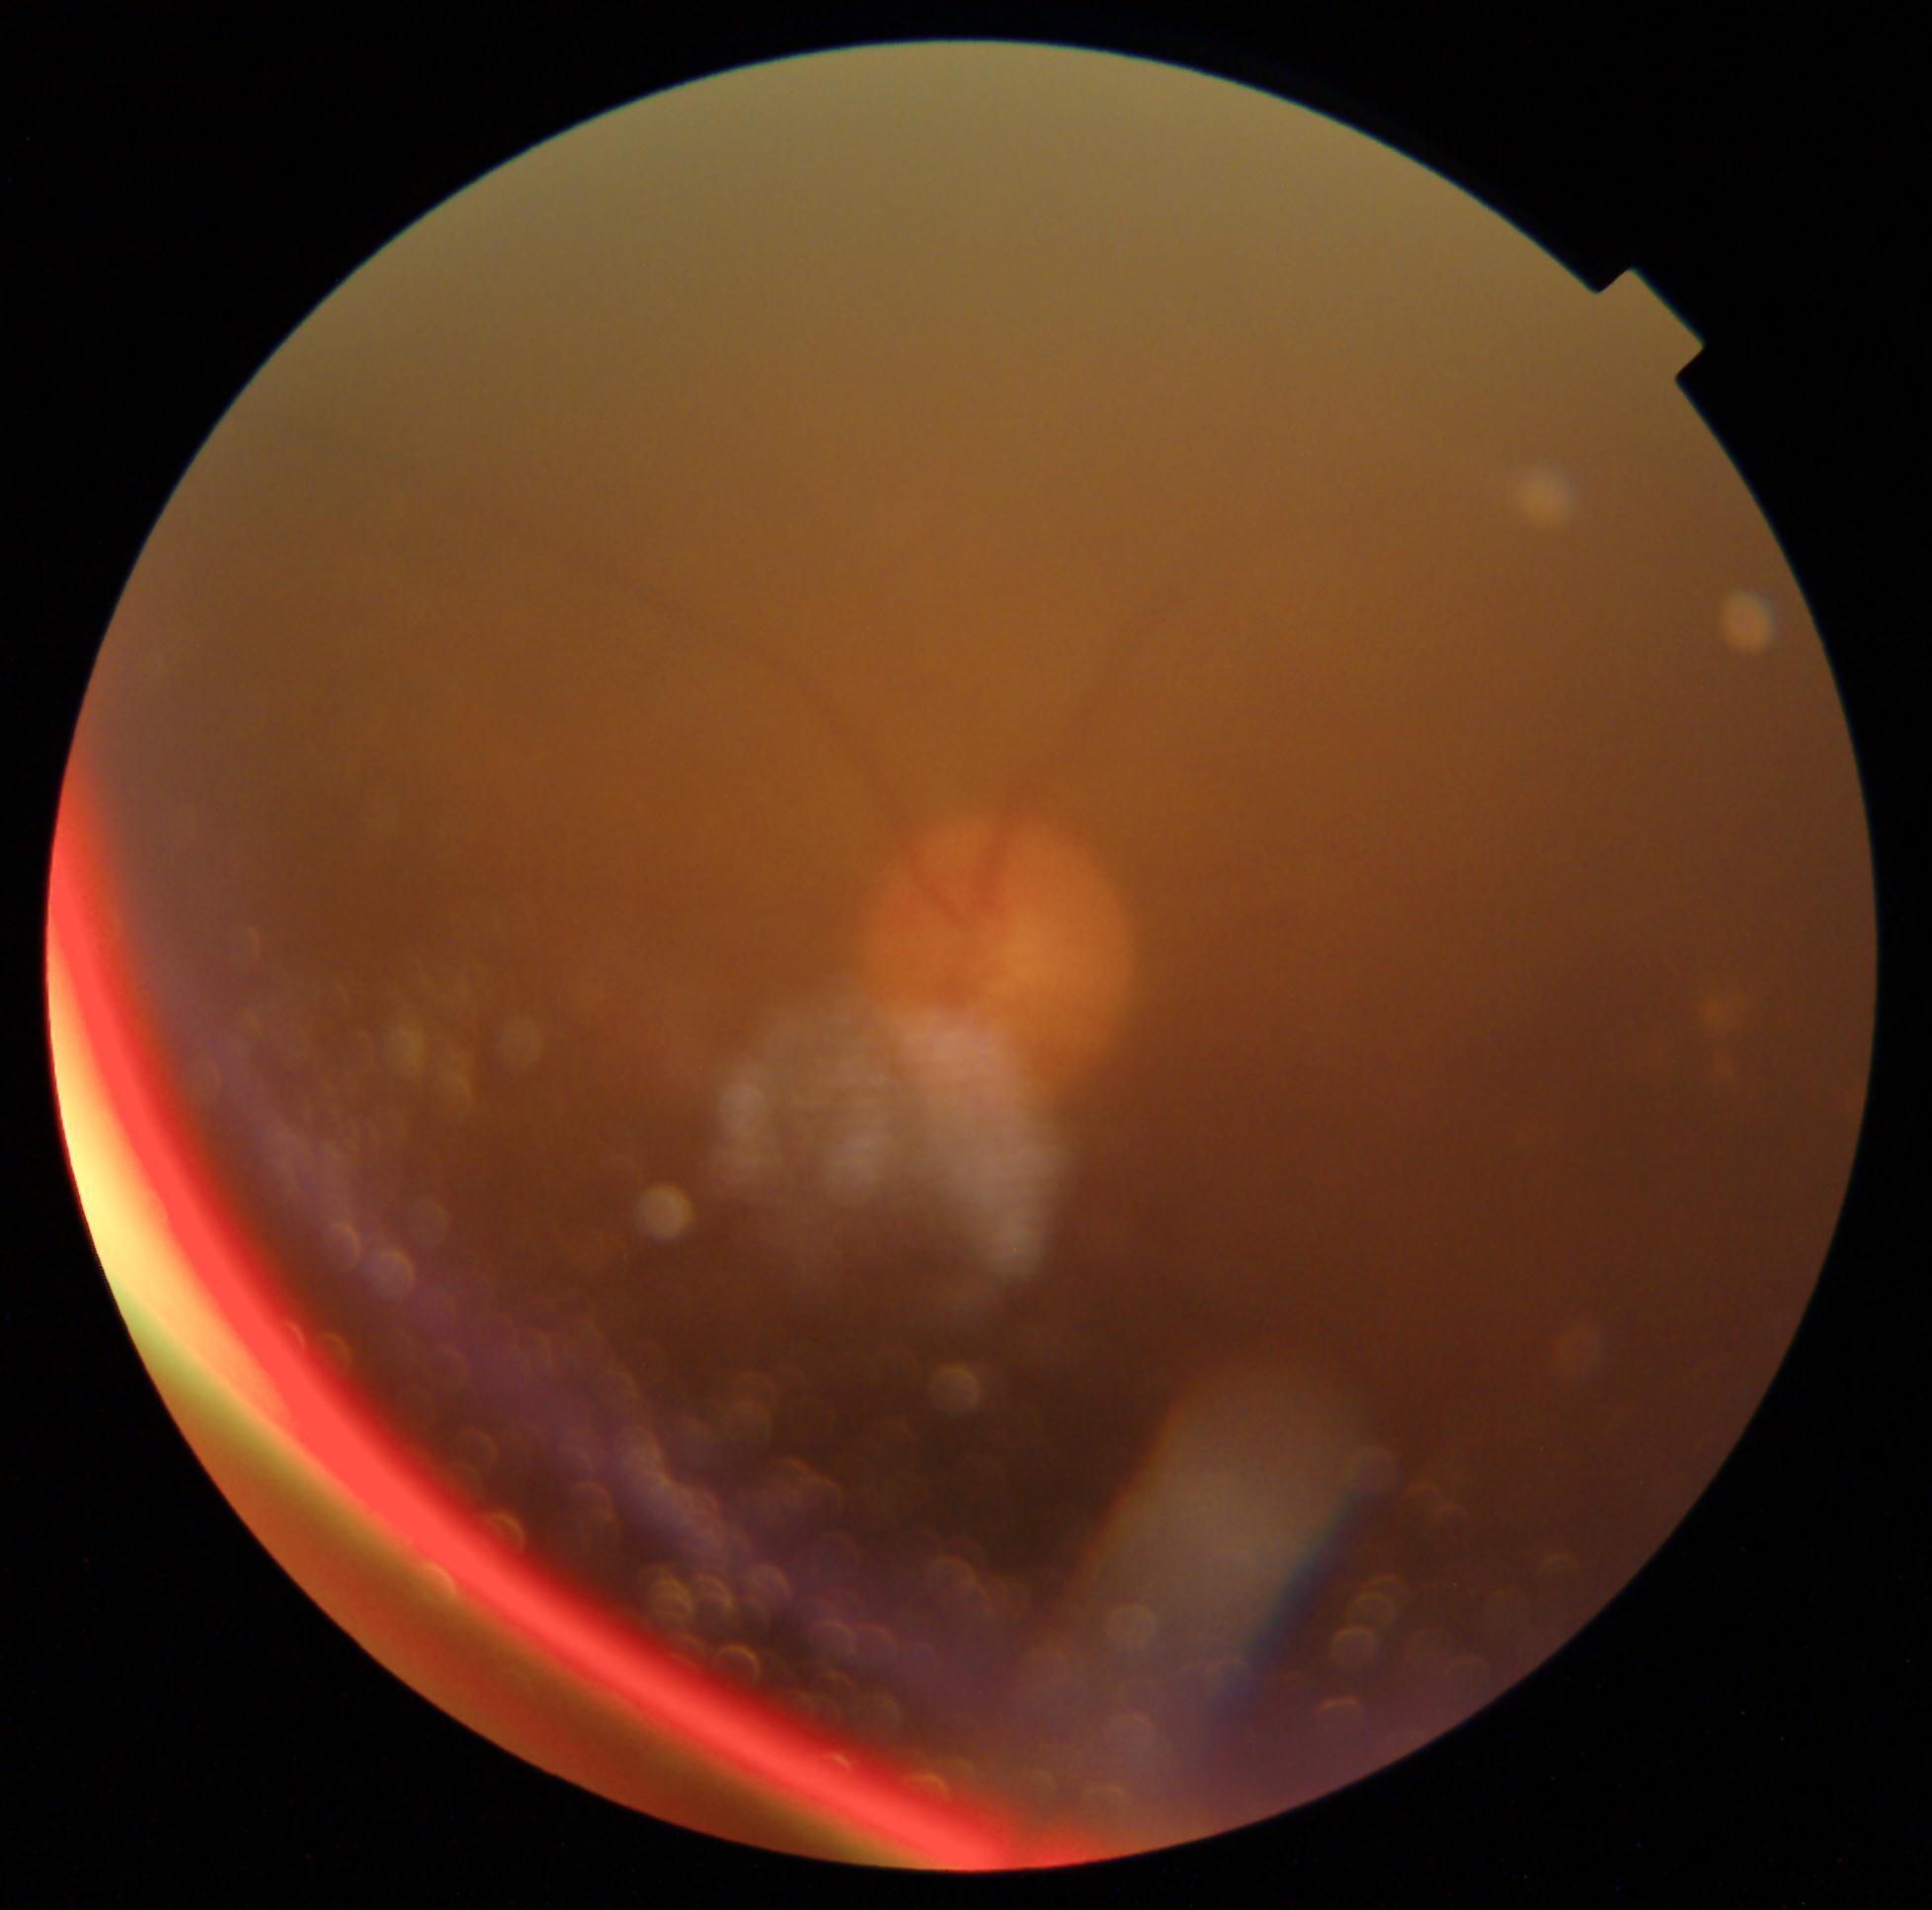

Annotations:
• DR severity: ungradable due to poor image quality
• image quality: insufficient for DR assessment